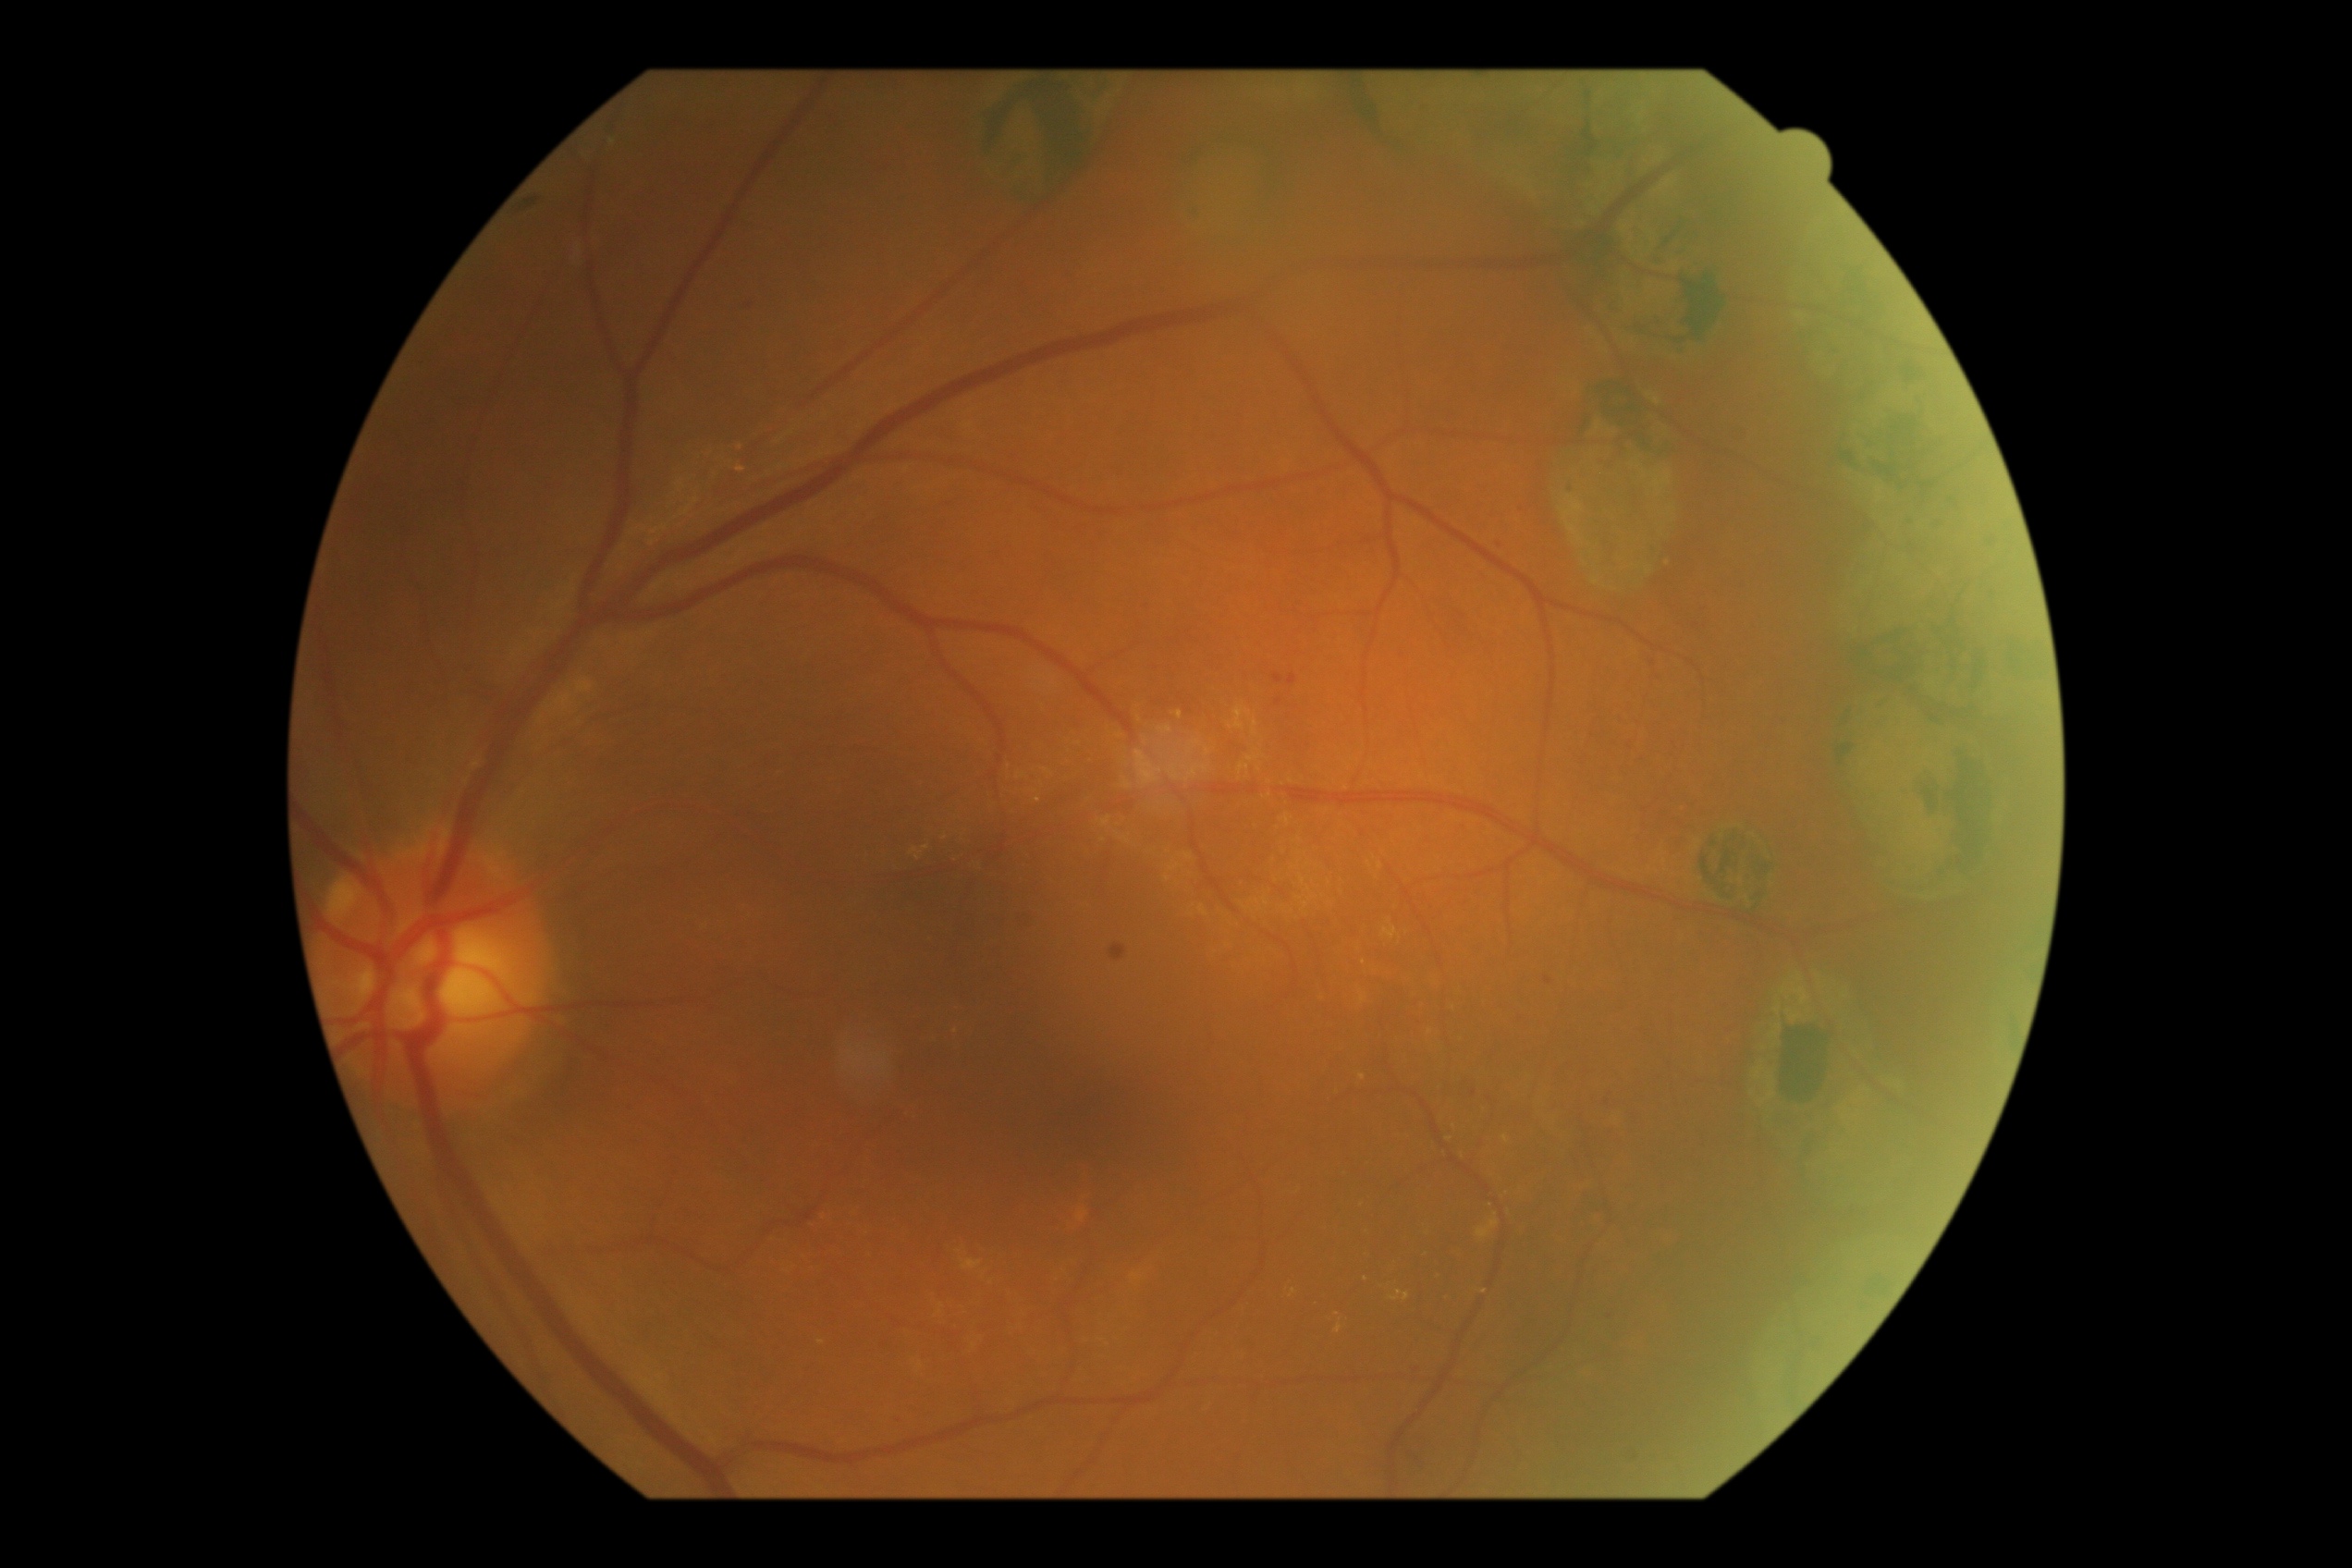

DR grade is 1 (mild NPDR) — presence of microaneurysms only.
The retinopathy is classified as non-proliferative diabetic retinopathy.